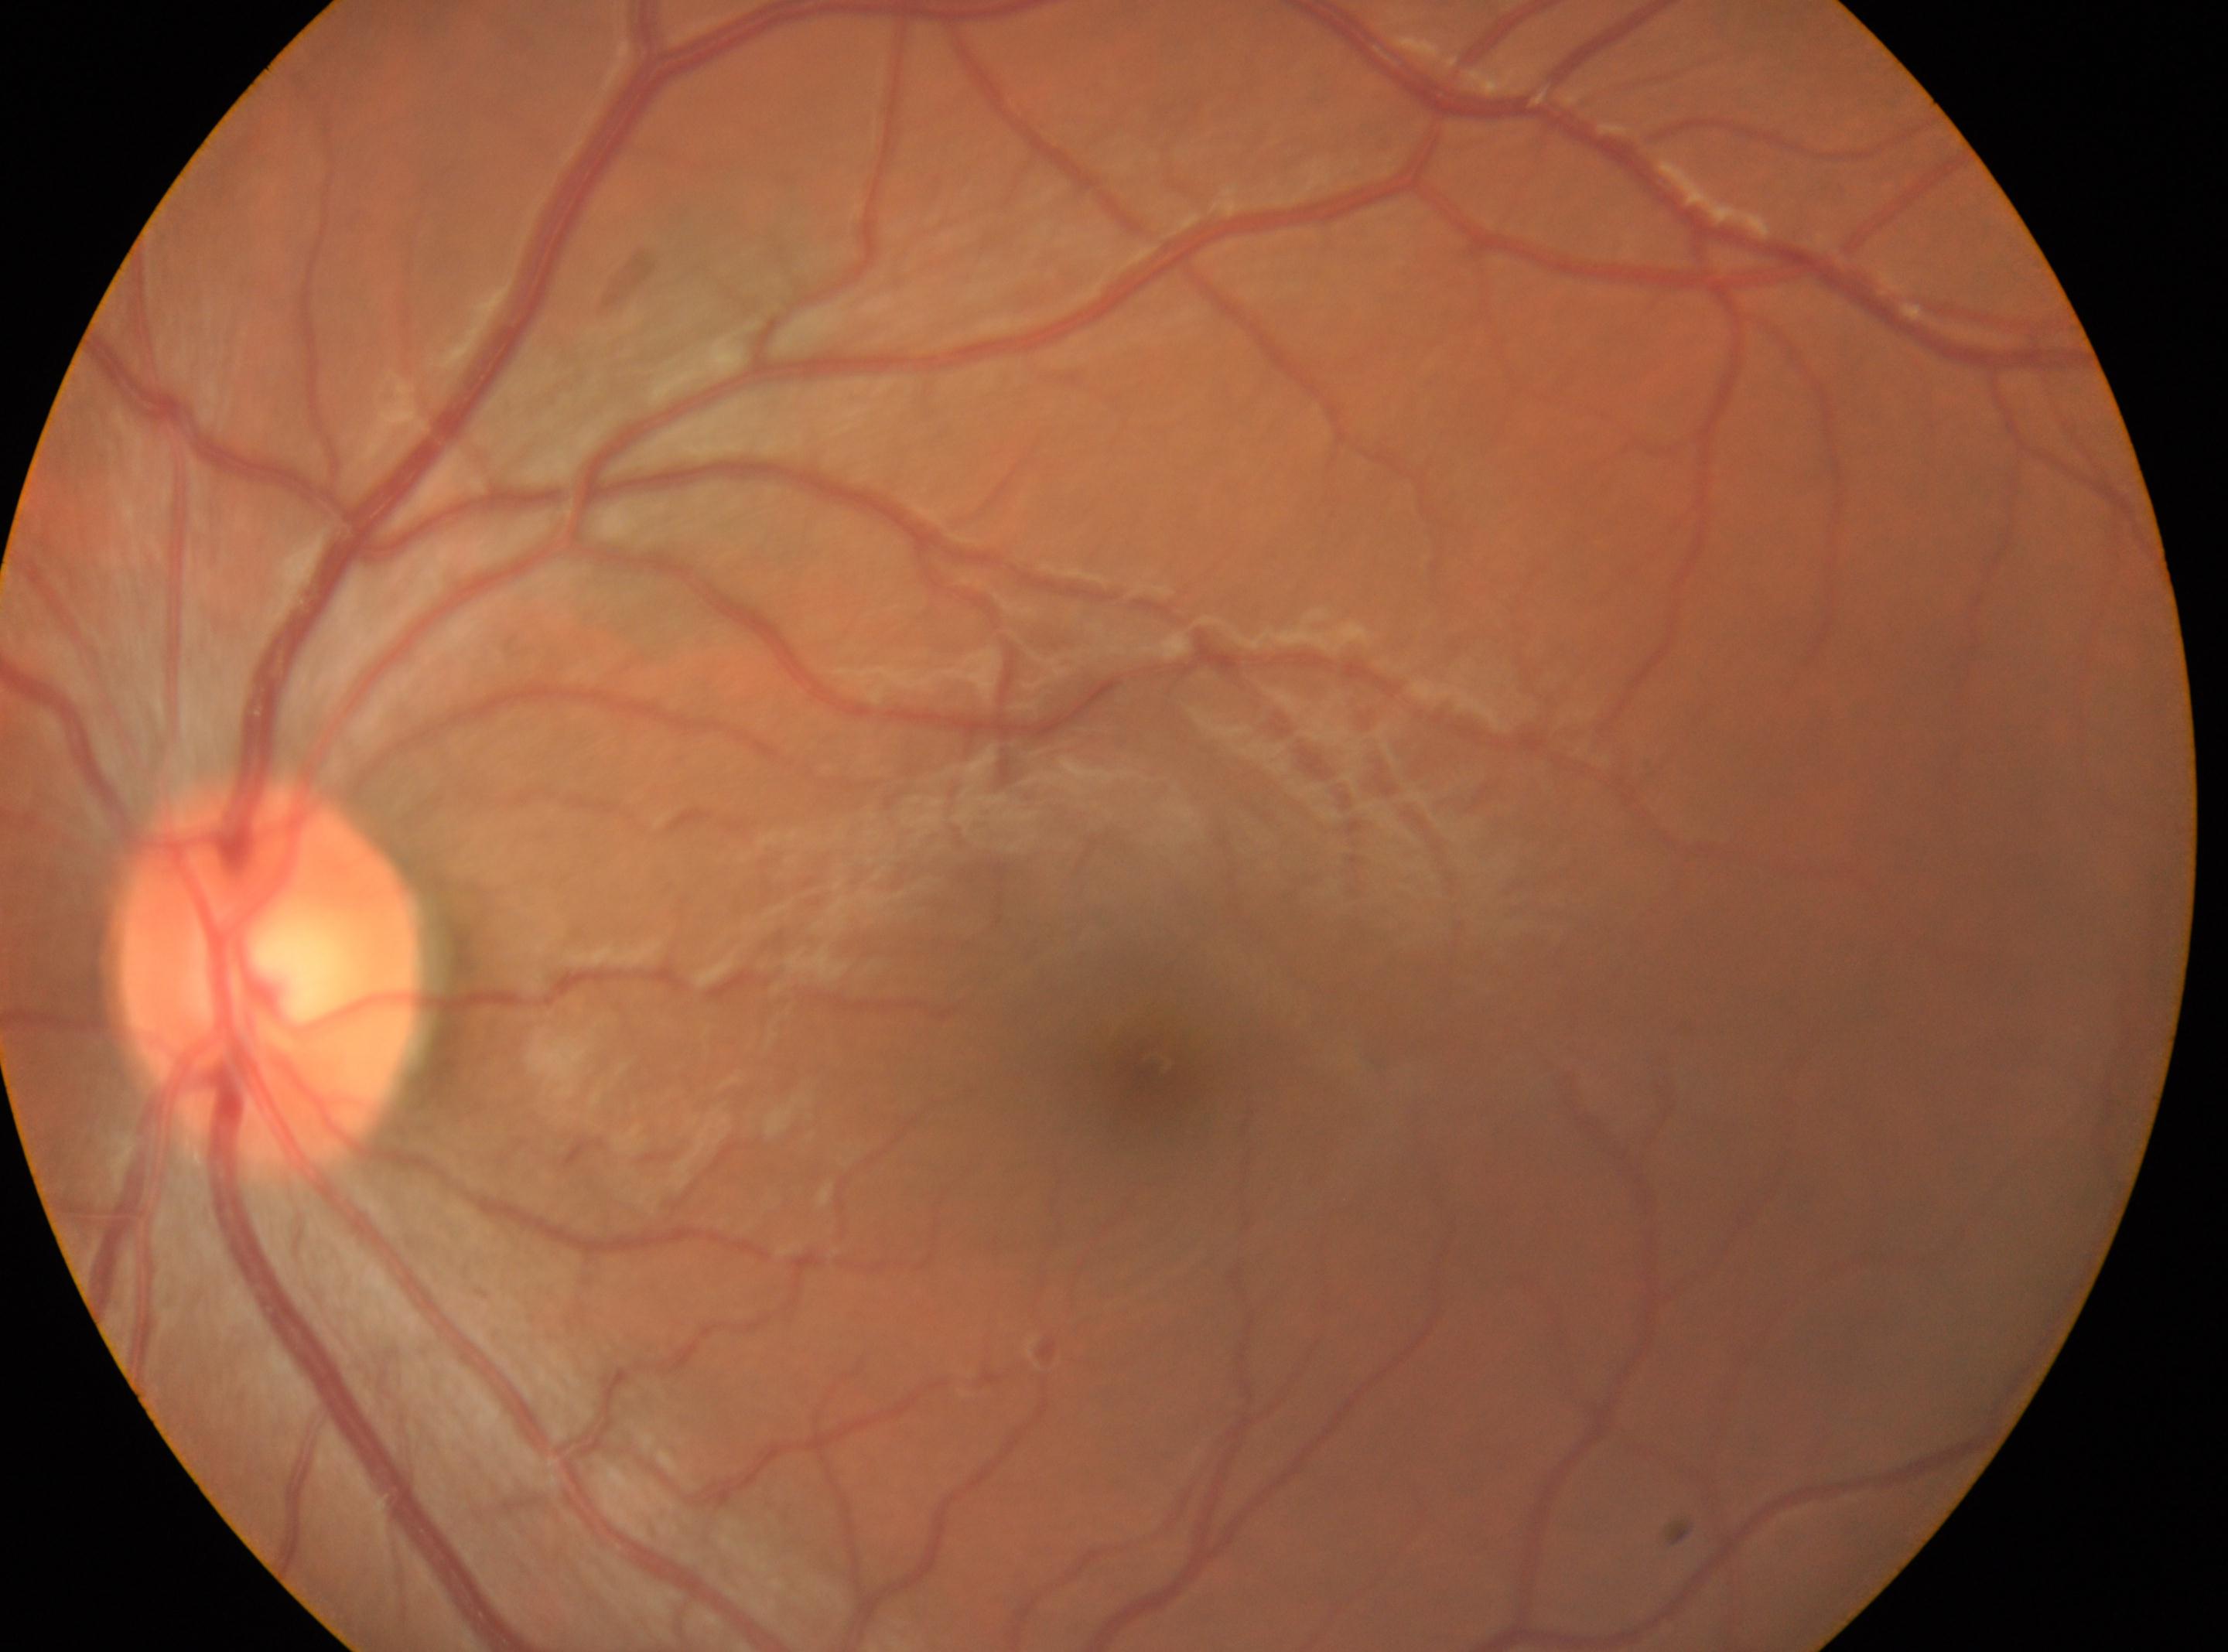 Eye: left. The macula center is at (x=1153, y=1064). DR severity: 0. The optic nerve head is at (x=266, y=976).